CFP
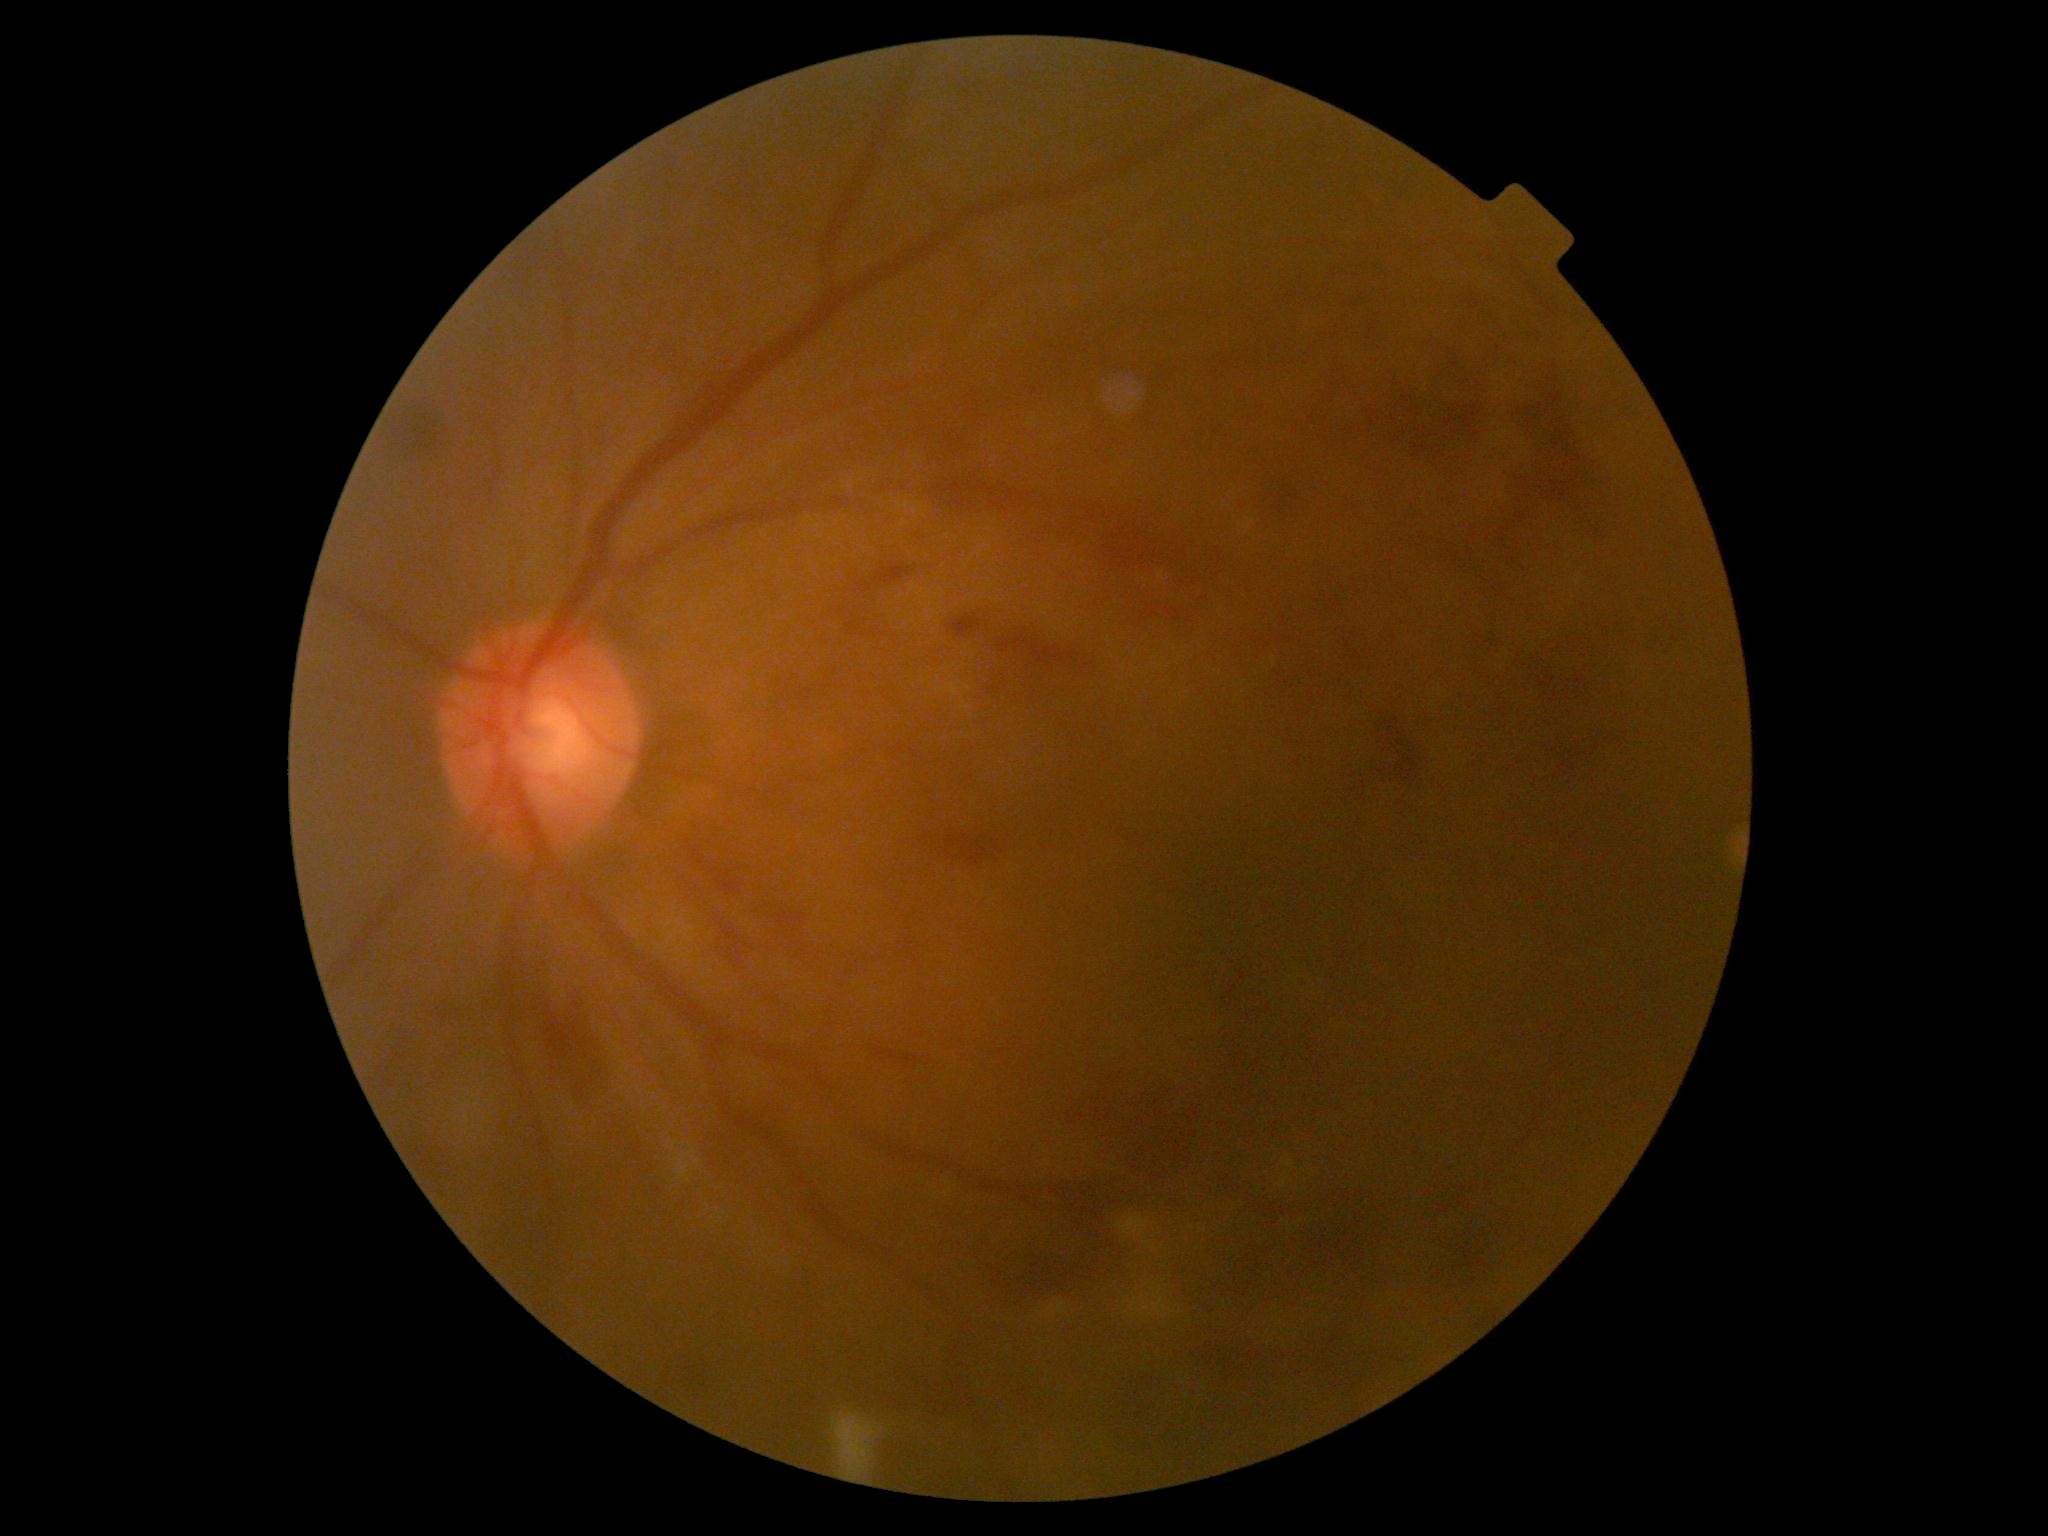 diabetic retinopathy severity = severe NPDR (grade 3) — more than 20 intraretinal hemorrhages in each of 4 quadrants, definite venous beading in 2 or more quadrants, or prominent intraretinal microvascular abnormalities in 1 or more quadrants, with no signs of proliferative retinopathy